50° field of view. 2361 x 1568 pixels. Kowa VX-10α. Dilated-pupil acquisition:
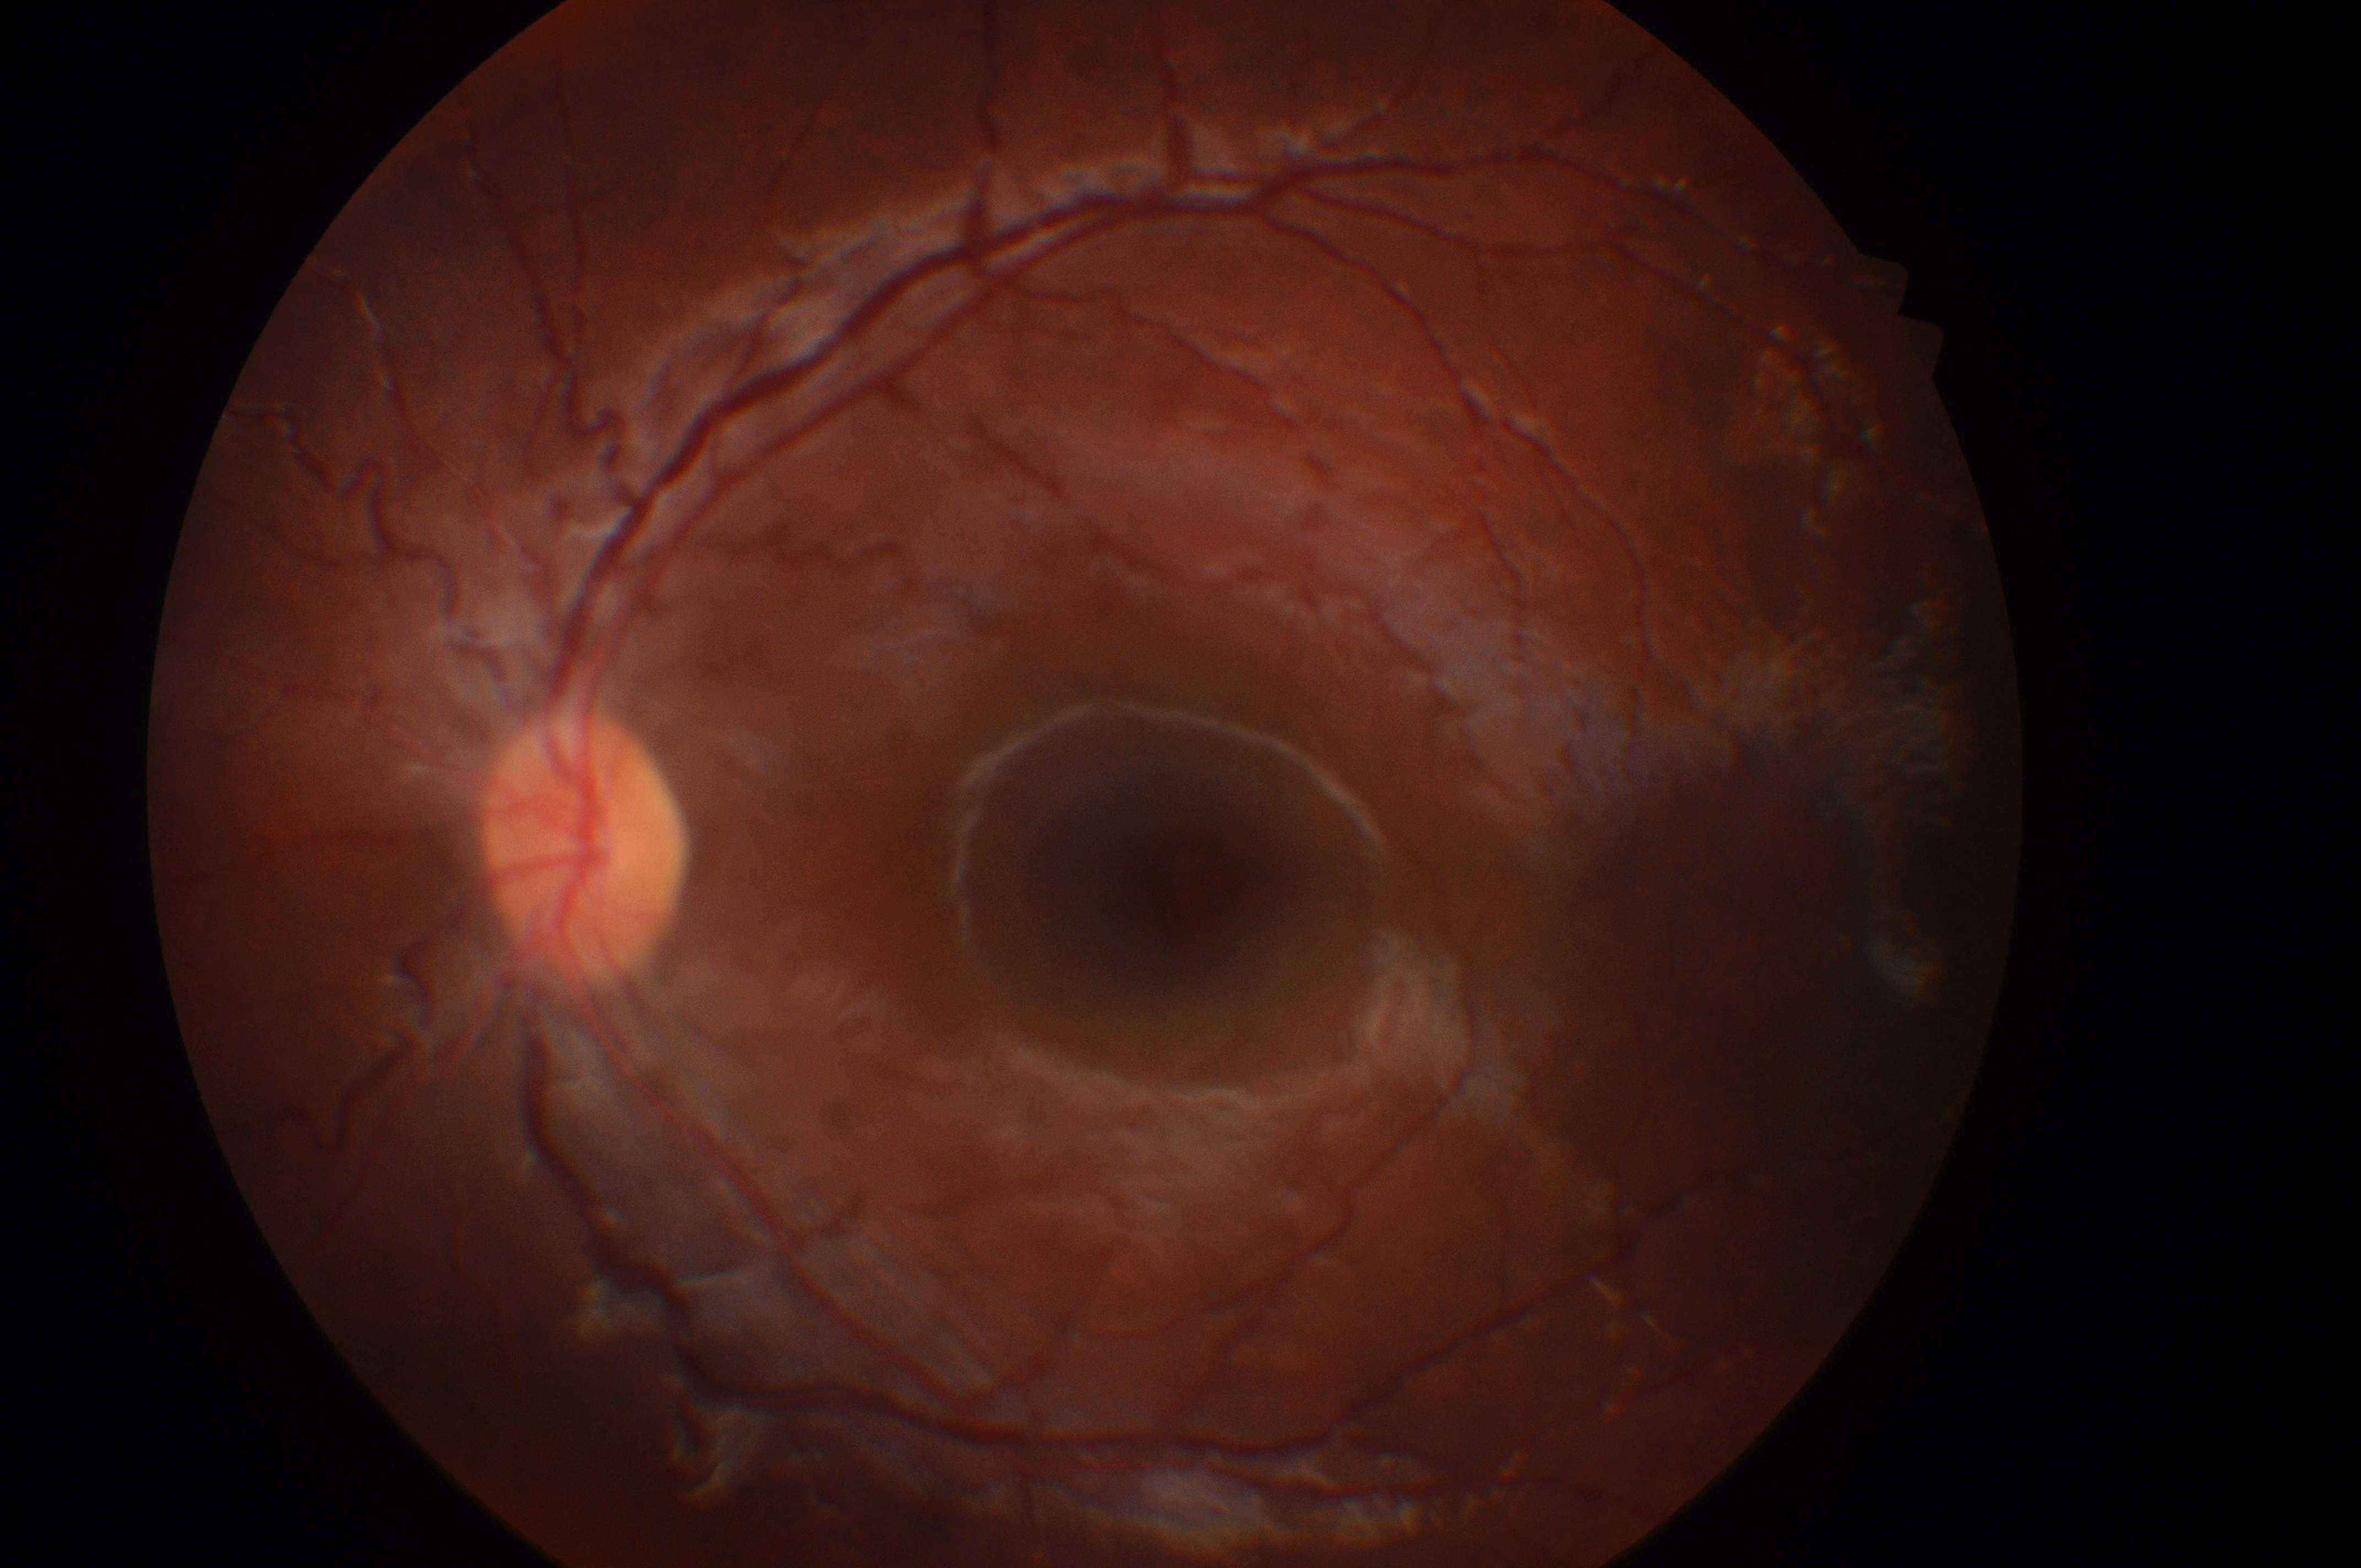 | field | value |
|---|---|
| the optic disc | (x: 581, y: 858) |
| DME risk | 0 |
| laterality | the left eye |
| DR grade | 0 |
| the fovea | (x: 1182, y: 880) |